Diabetic retinopathy graded by the modified Davis classification.
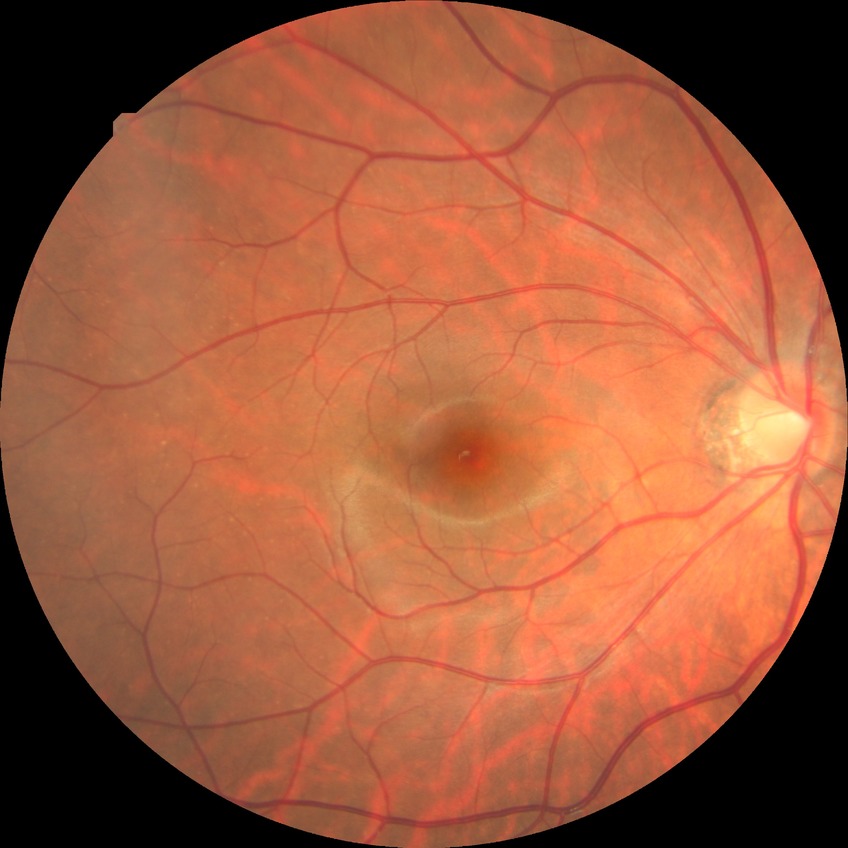

Diabetic retinopathy severity: no diabetic retinopathy.